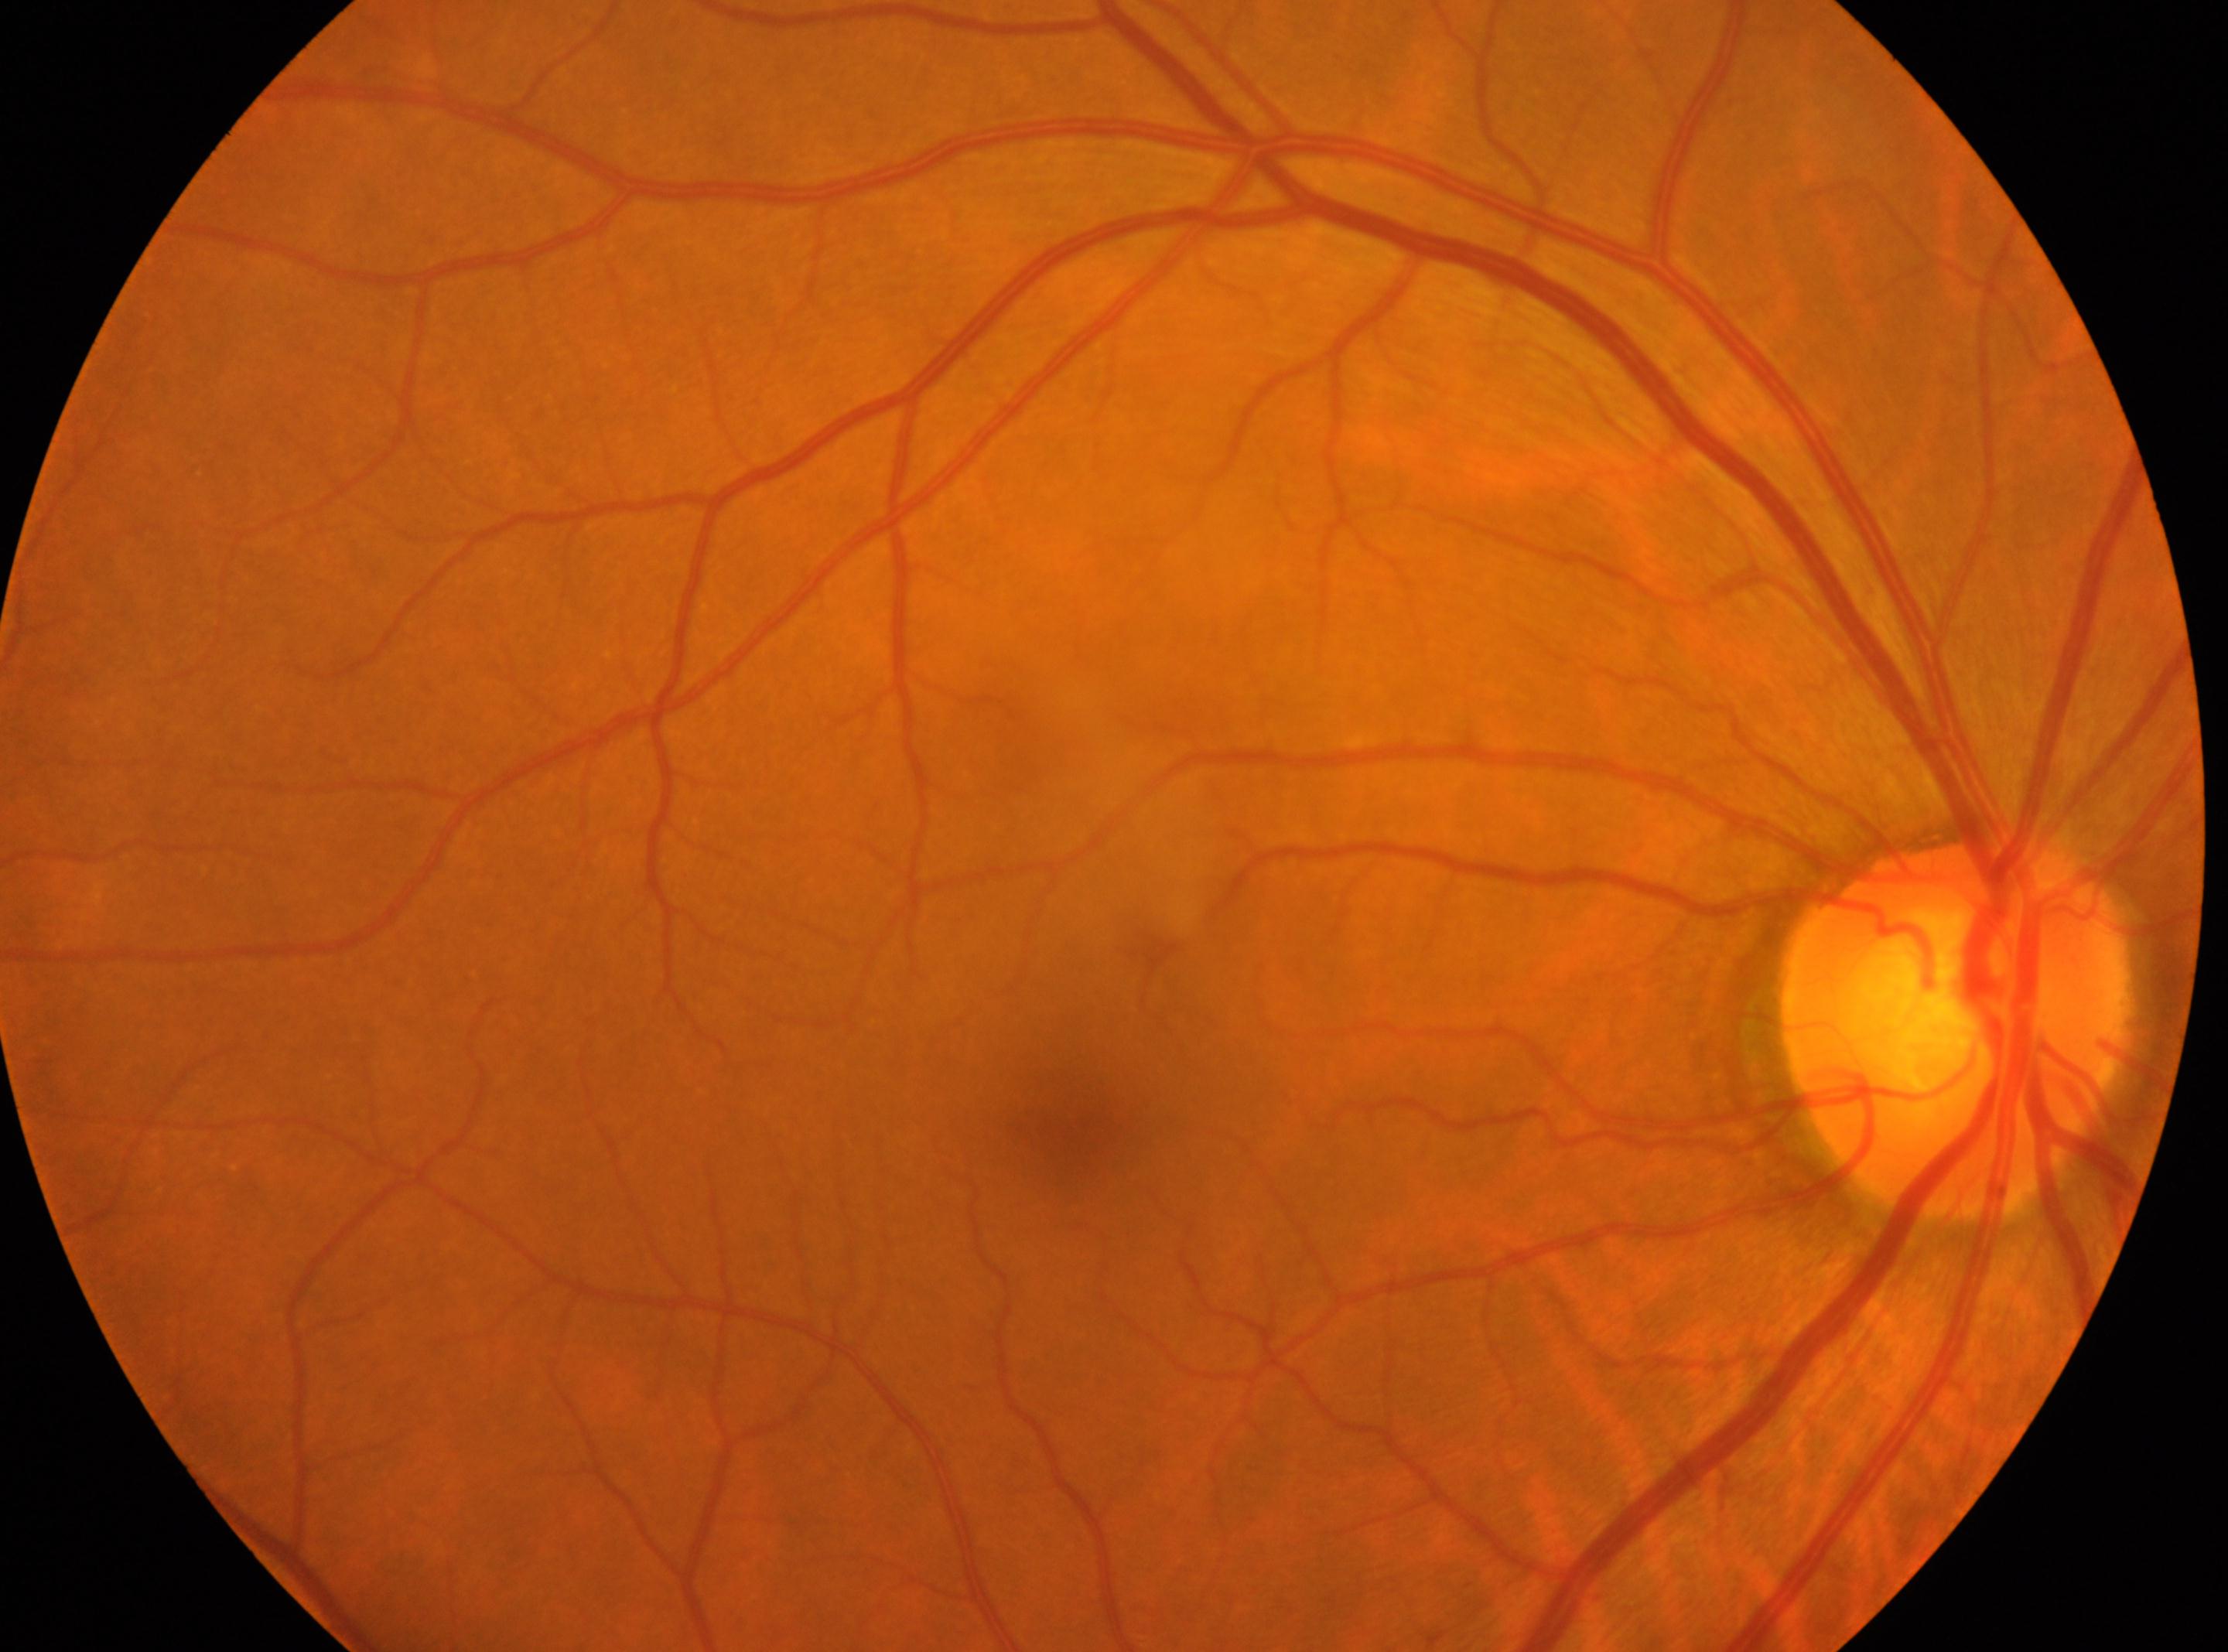

Eye: right eye. No signs of diabetic retinopathy. Optic disc center: (x: 1956, y: 1024). DR severity: grade 0. Fovea located at (x: 1066, y: 1114).